45° field of view, graded on the modified Davis scale
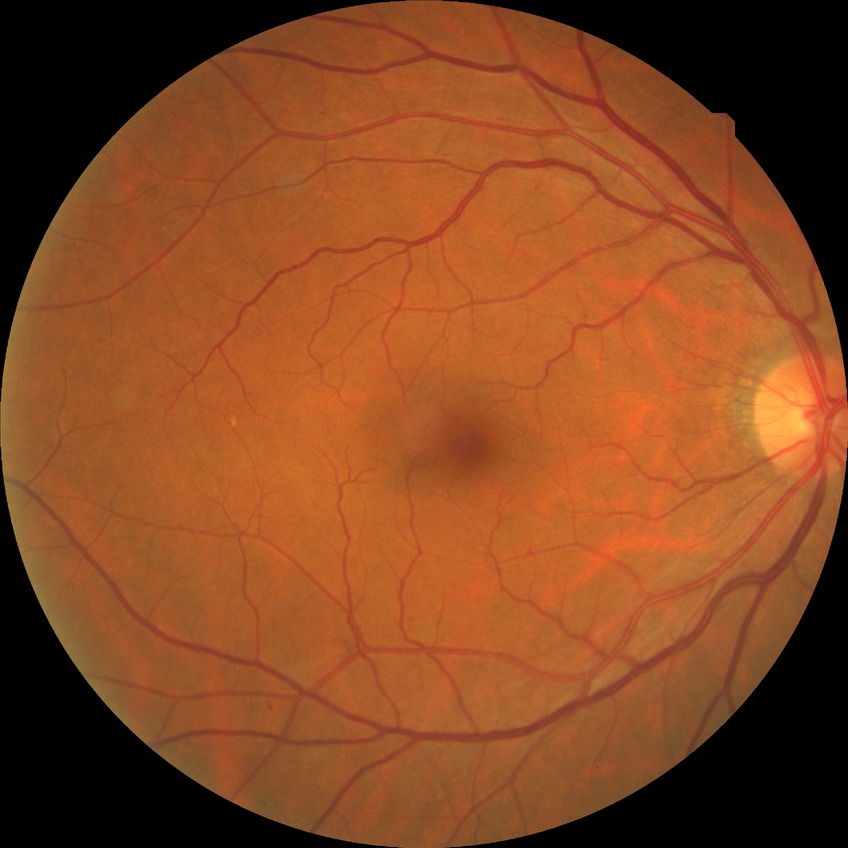 diabetic retinopathy (DR) = NDR (no diabetic retinopathy)